Portable fundus photograph, 2212 by 1659 pixels, 60° field of view:
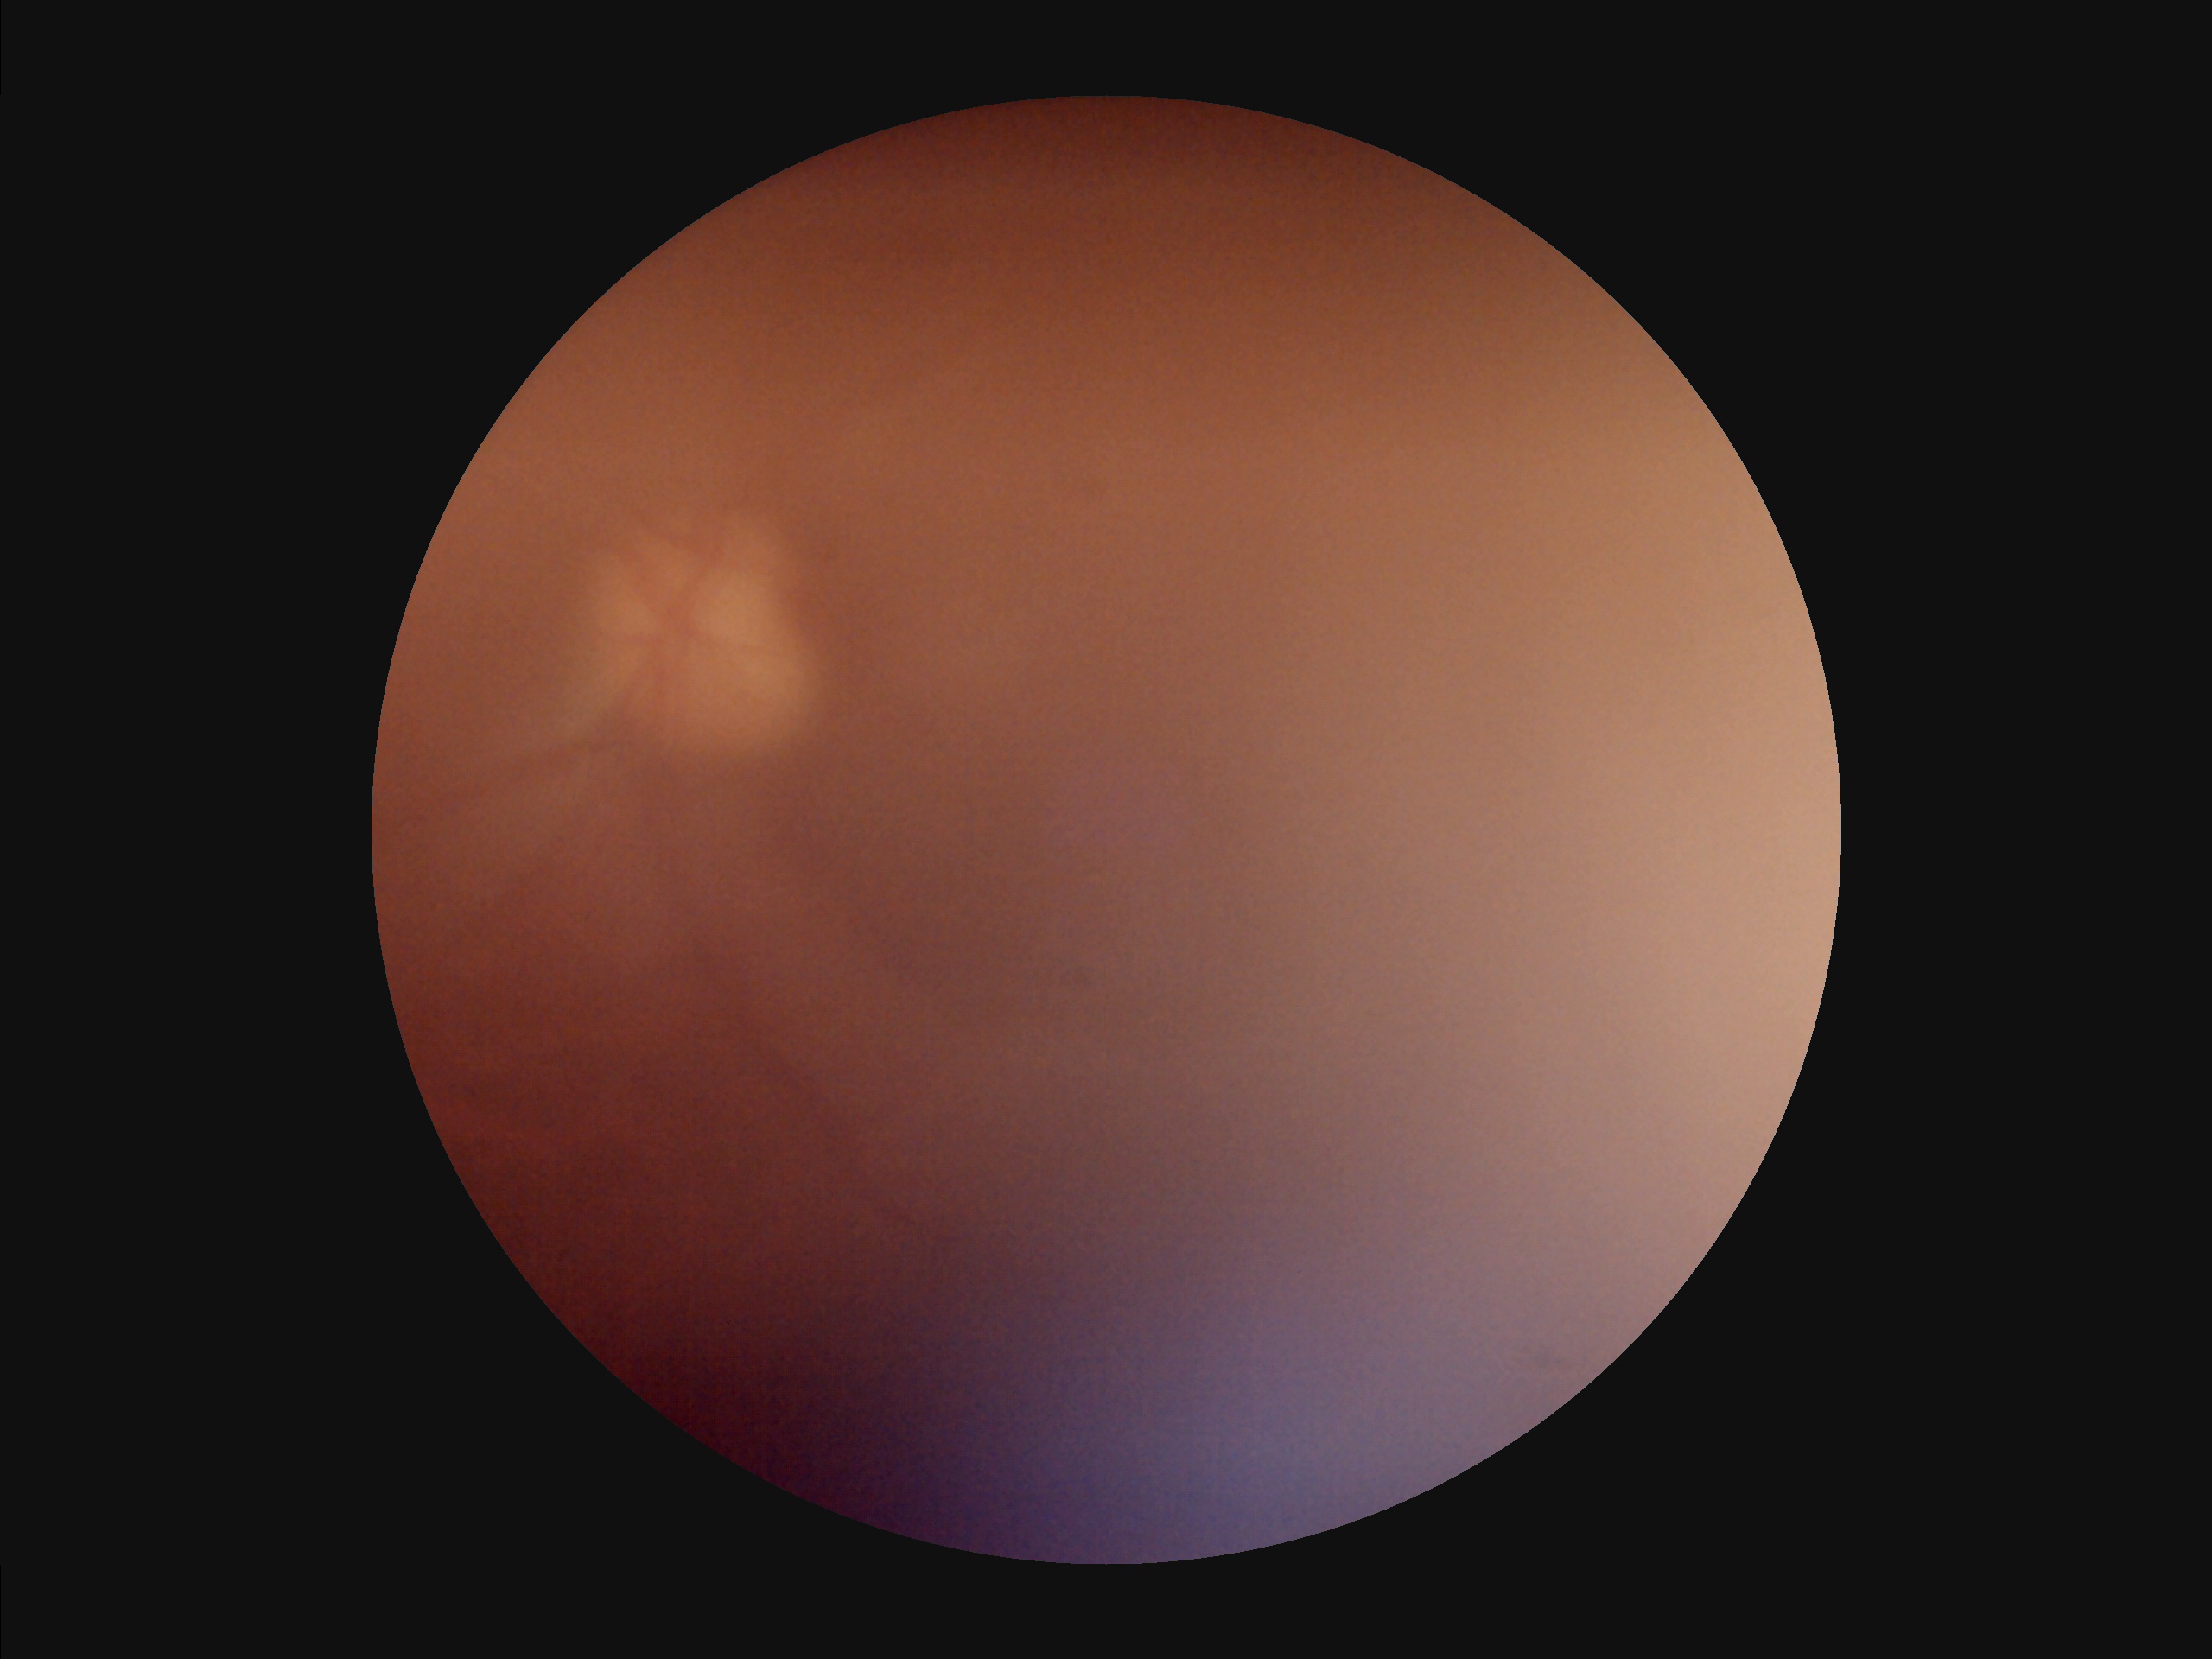

Image quality: overall: suboptimal; illumination/color: suboptimal; contrast: reduced; clarity: out of focus.